Davis DR grading:
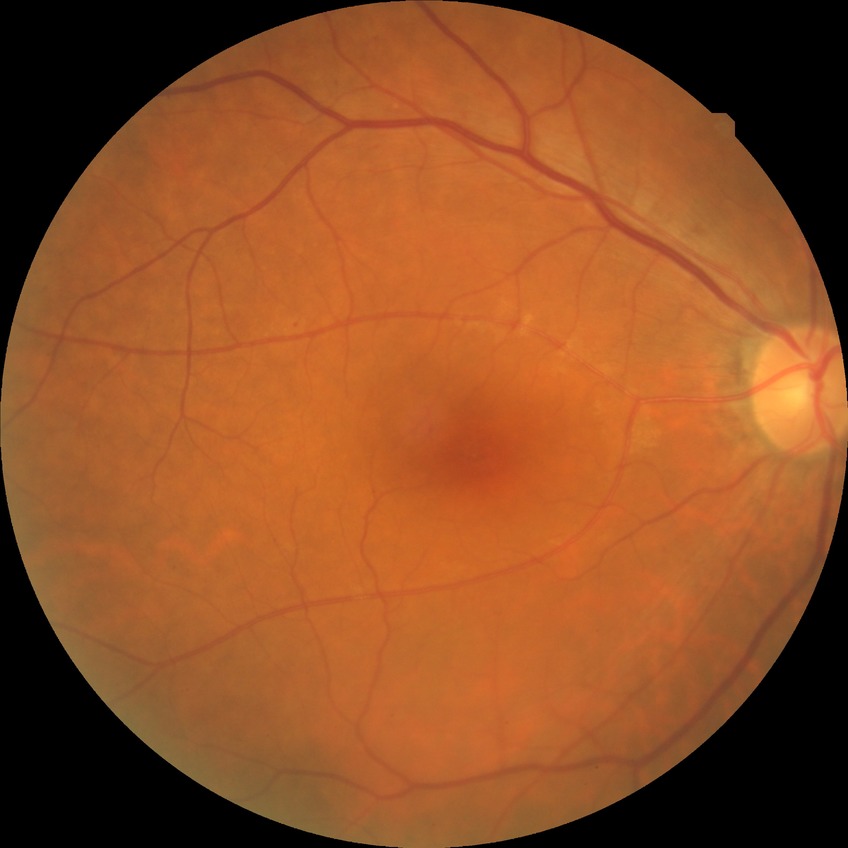   davis_grade: SDR (simple diabetic retinopathy)
  proliferative_class: non-proliferative diabetic retinopathy